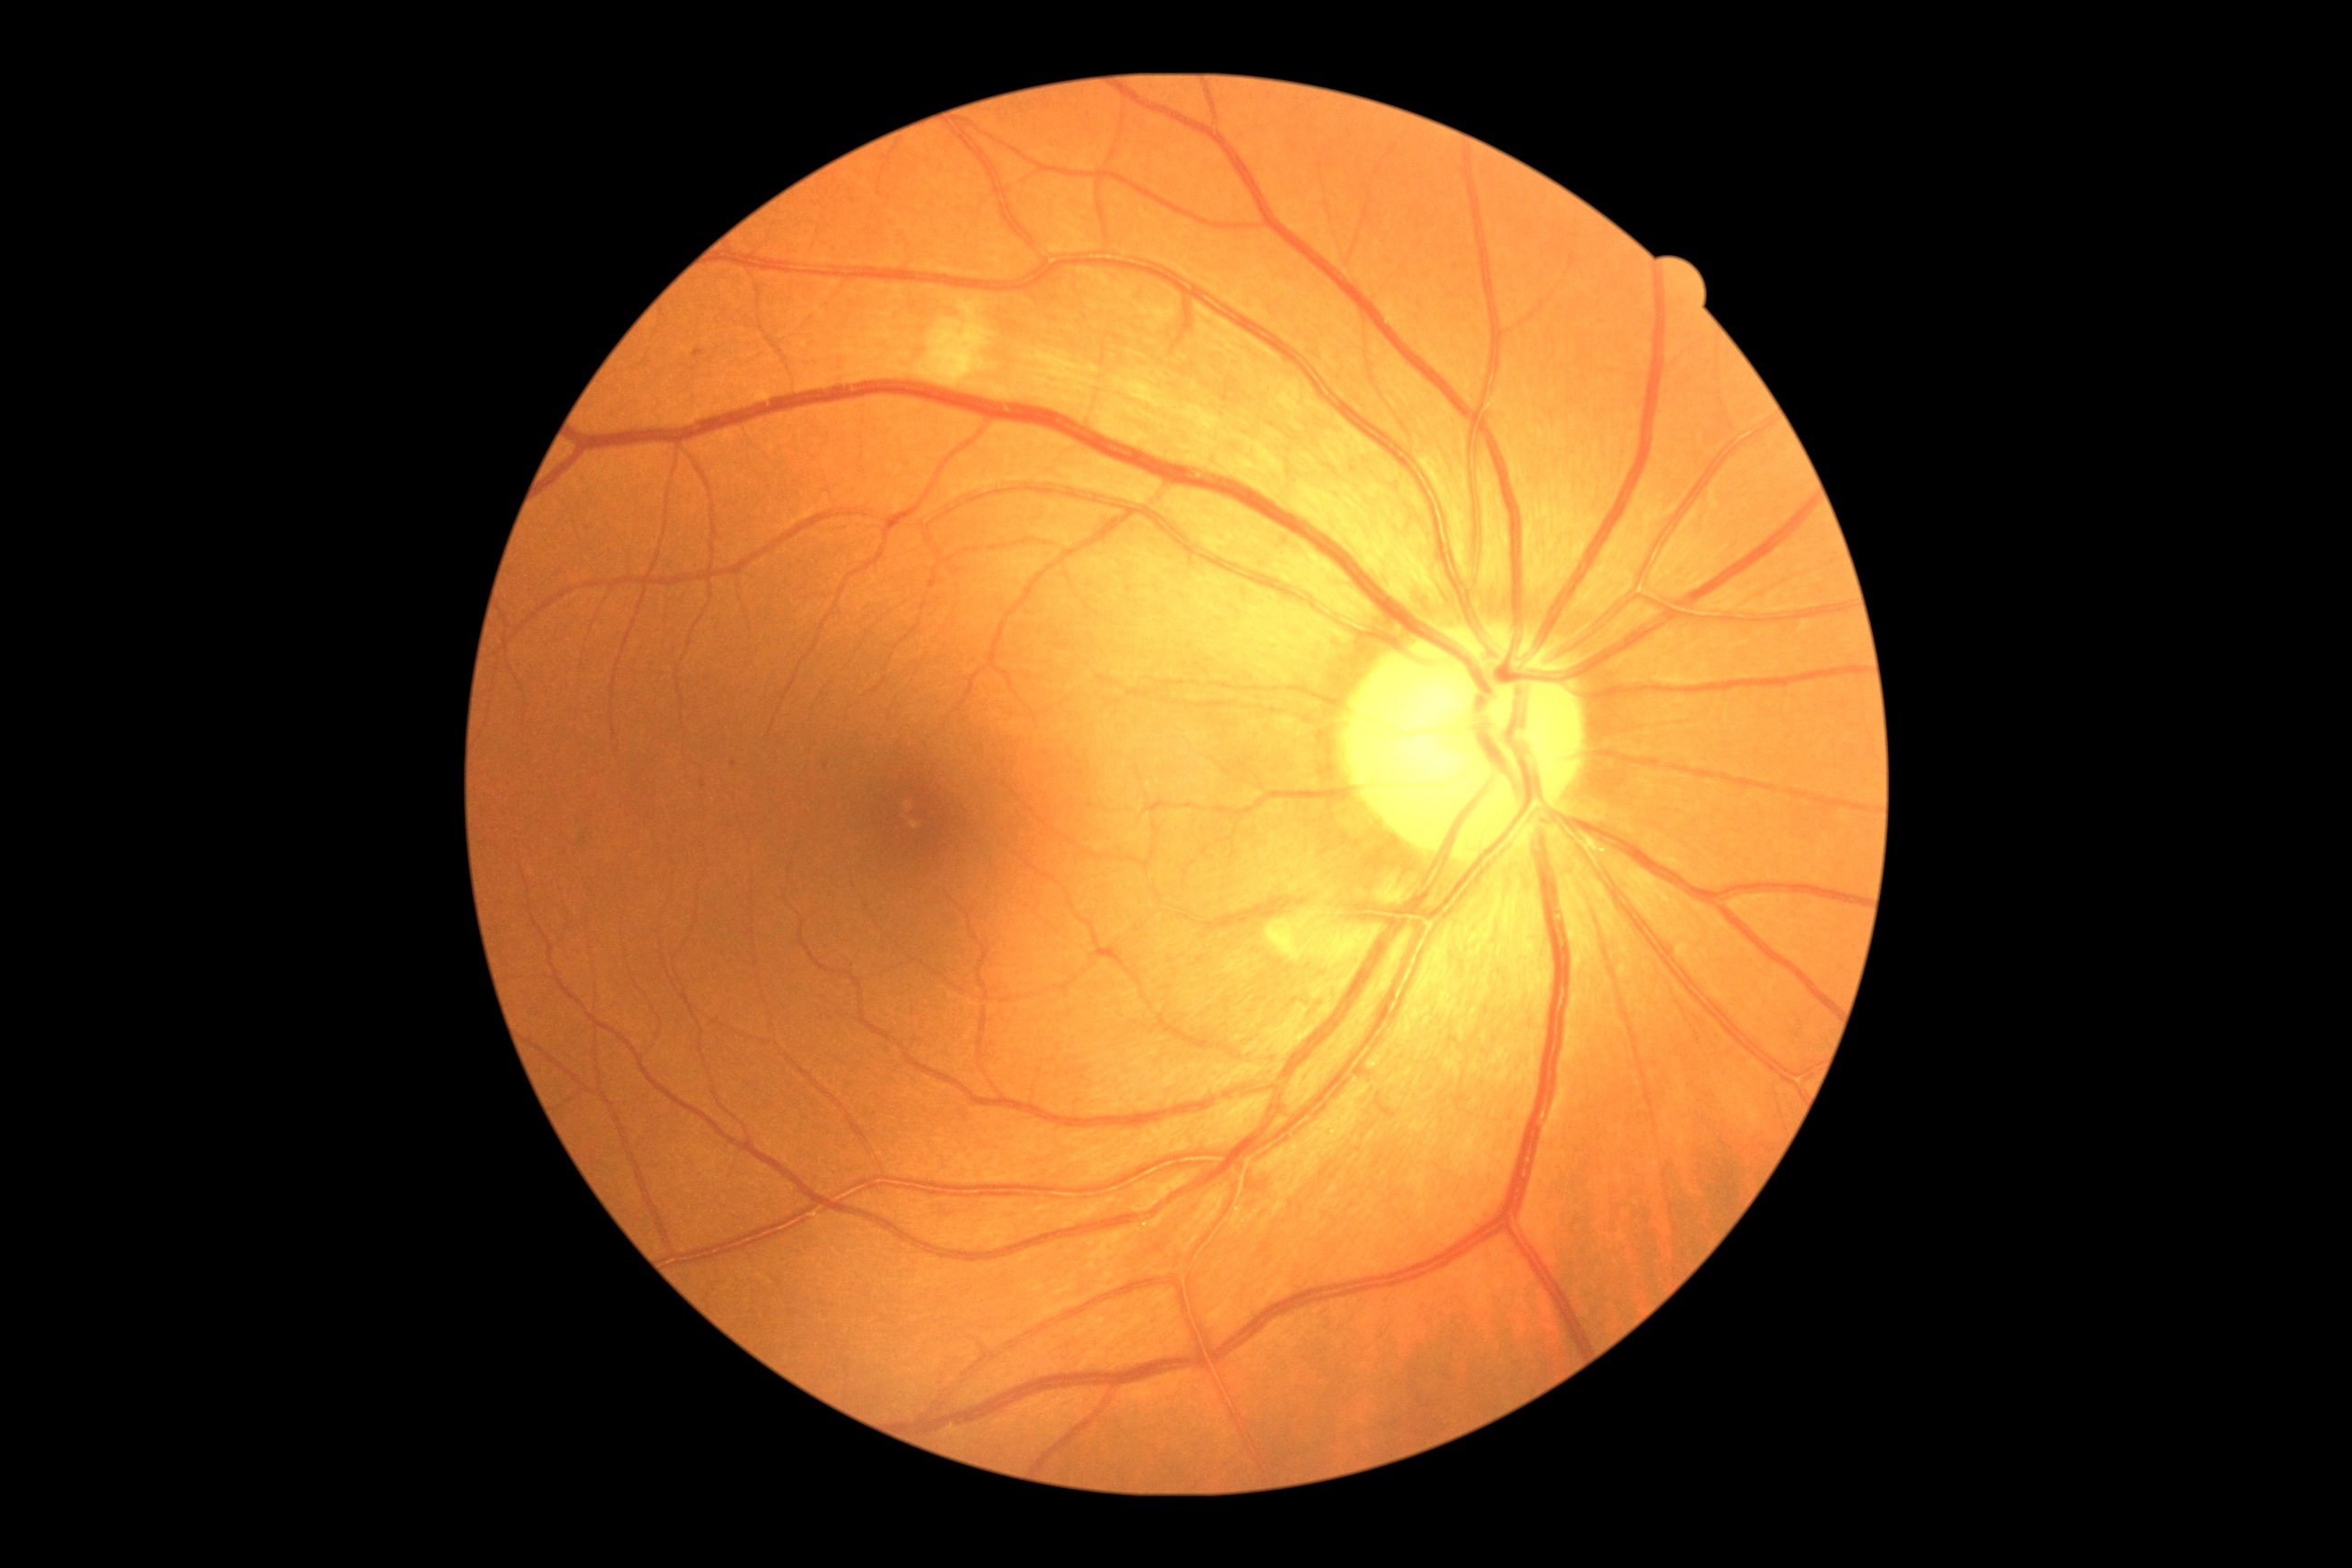
DR class: non-proliferative diabetic retinopathy
DR stage: 2